100° field of view (Phoenix ICON). Wide-field fundus photograph from neonatal ROP screening — 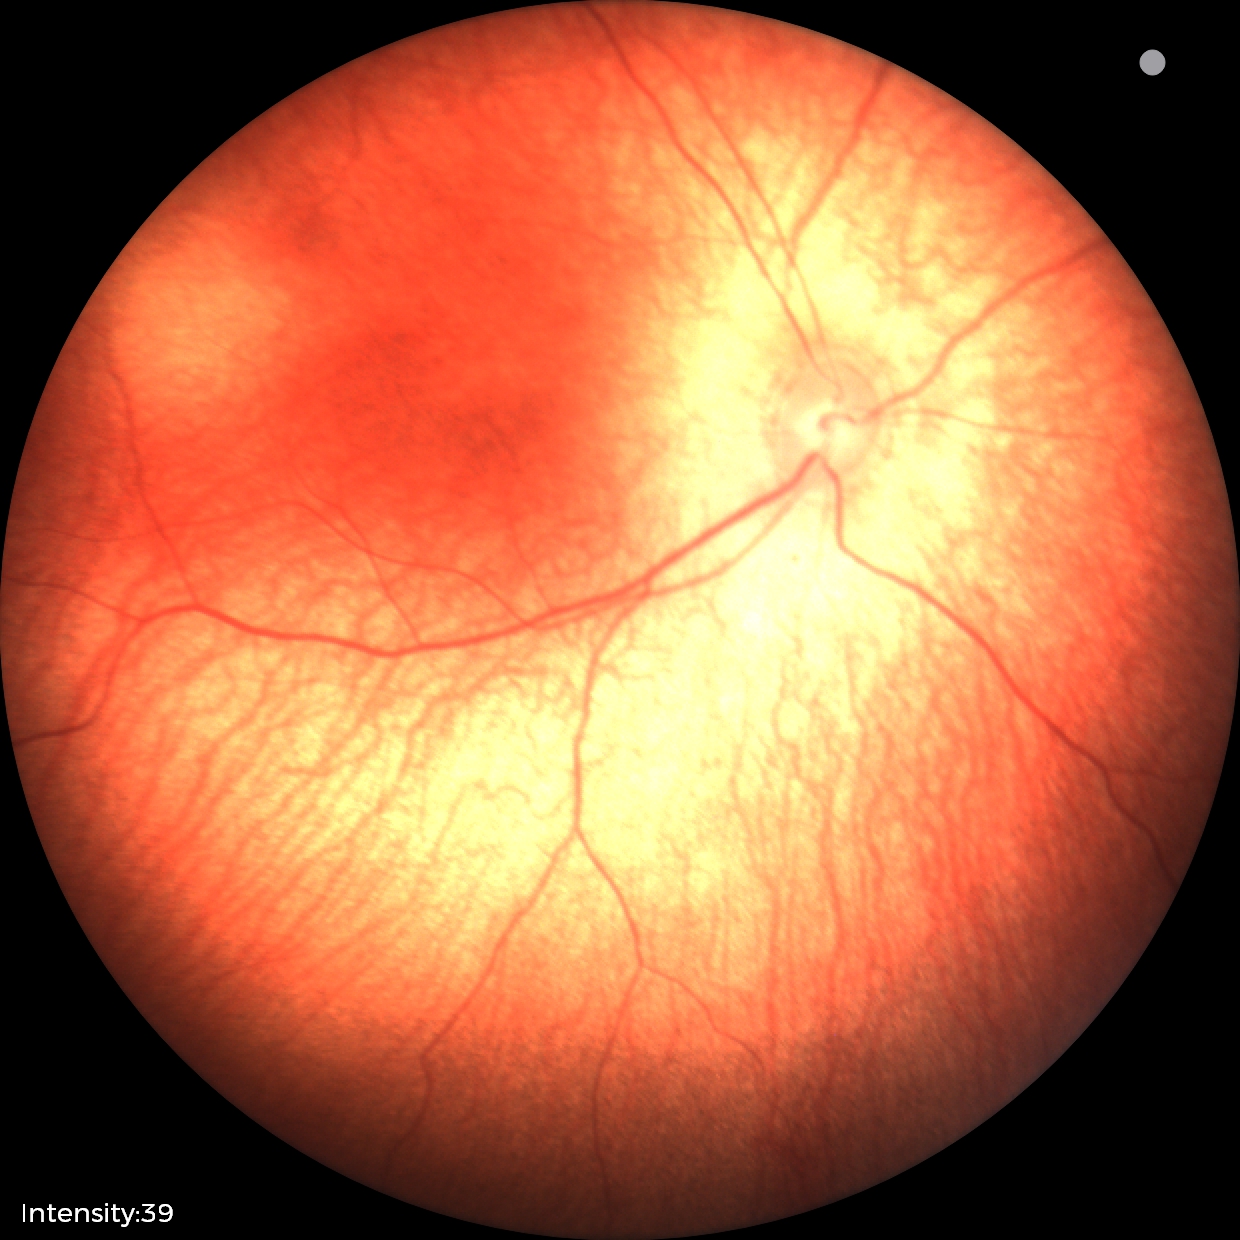

Normal screening examination.